Nonmydriatic fundus photograph, diabetic retinopathy graded by the modified Davis classification
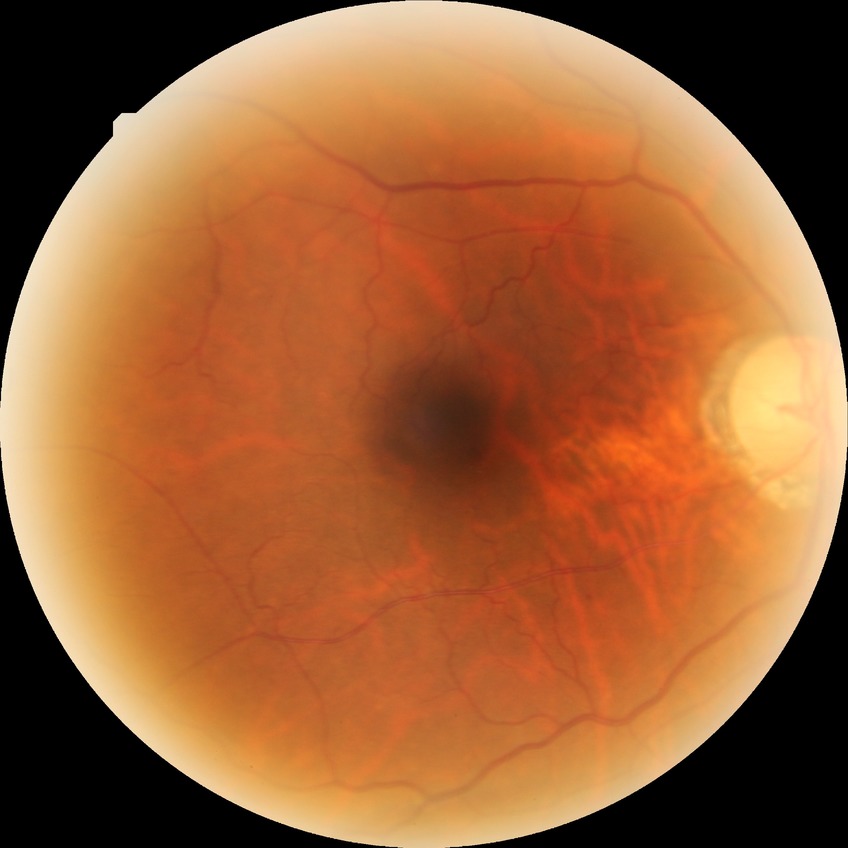
Davis stage = NDR, DR impression = no apparent DR.